Wide-field fundus photograph from neonatal ROP screening: 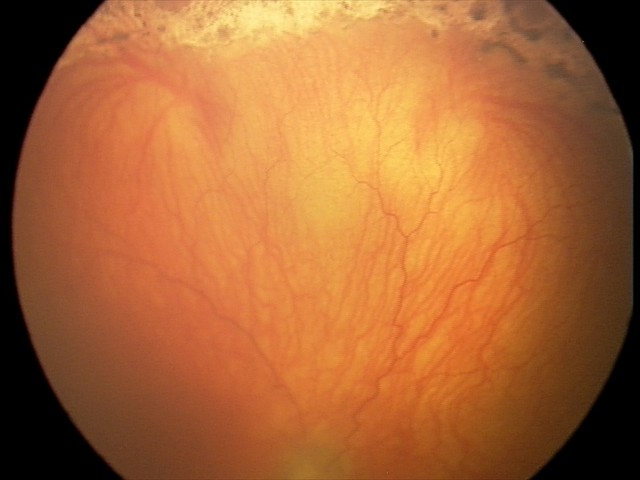

Screening series with aggressive ROP (A-ROP).